Wide-field fundus photograph from neonatal ROP screening; 640x480: 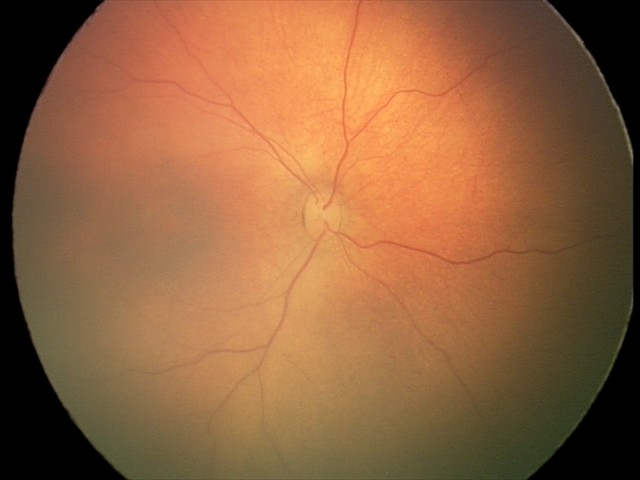
Normal screening examination.